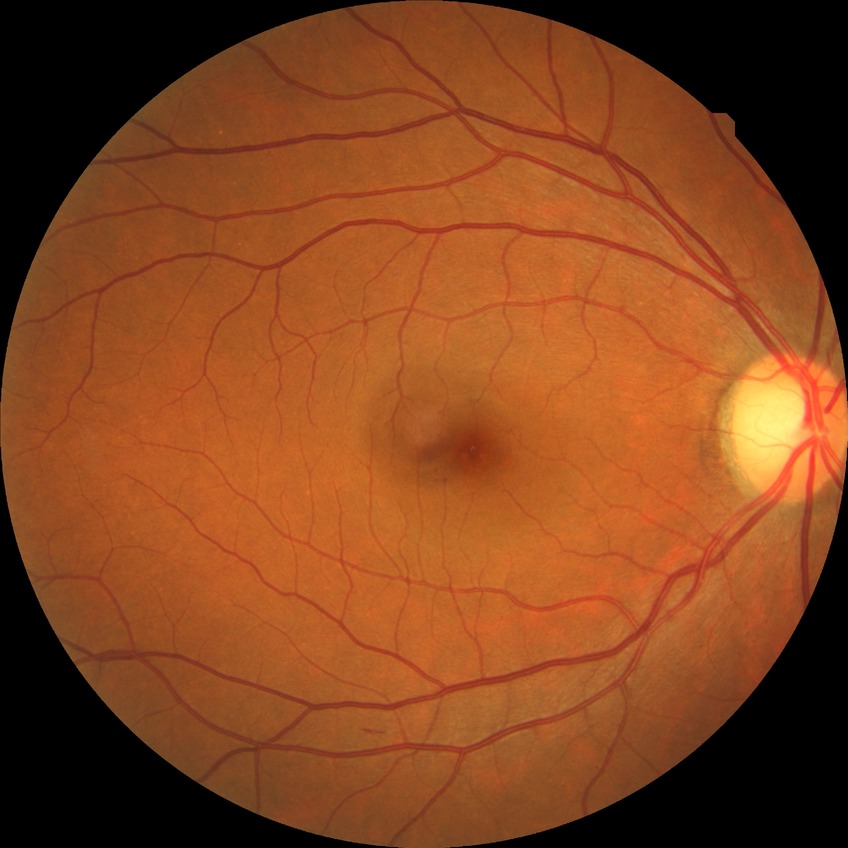
Davis stage is NDR.